CFP; Davis DR grading
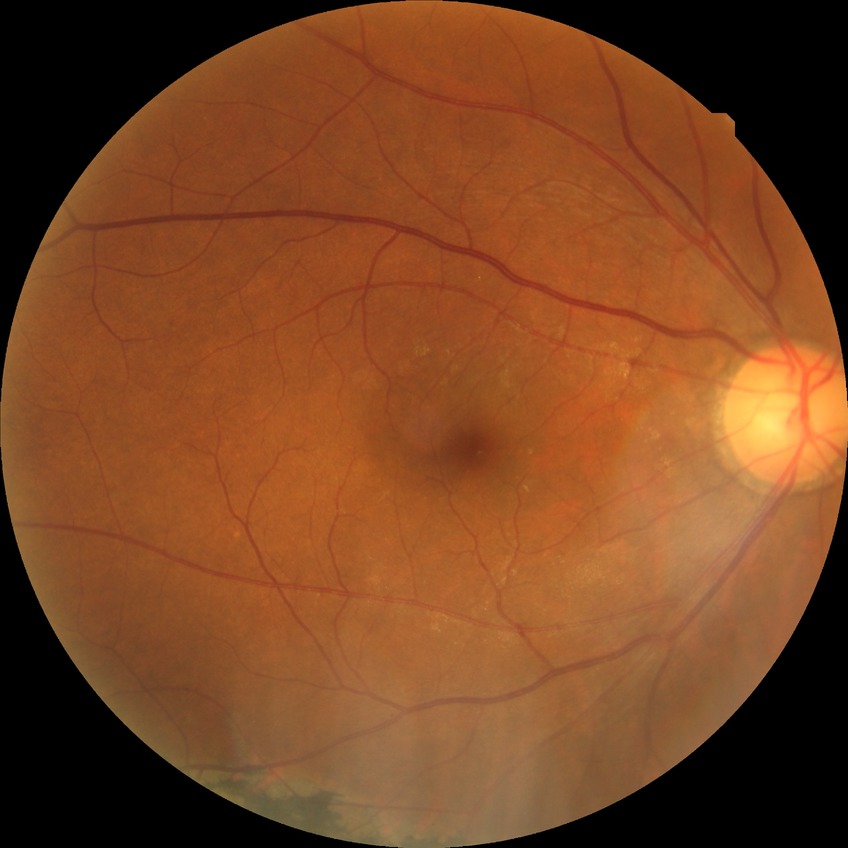

DR grade: NDR.
No DR findings.